1380 x 1382 pixels.
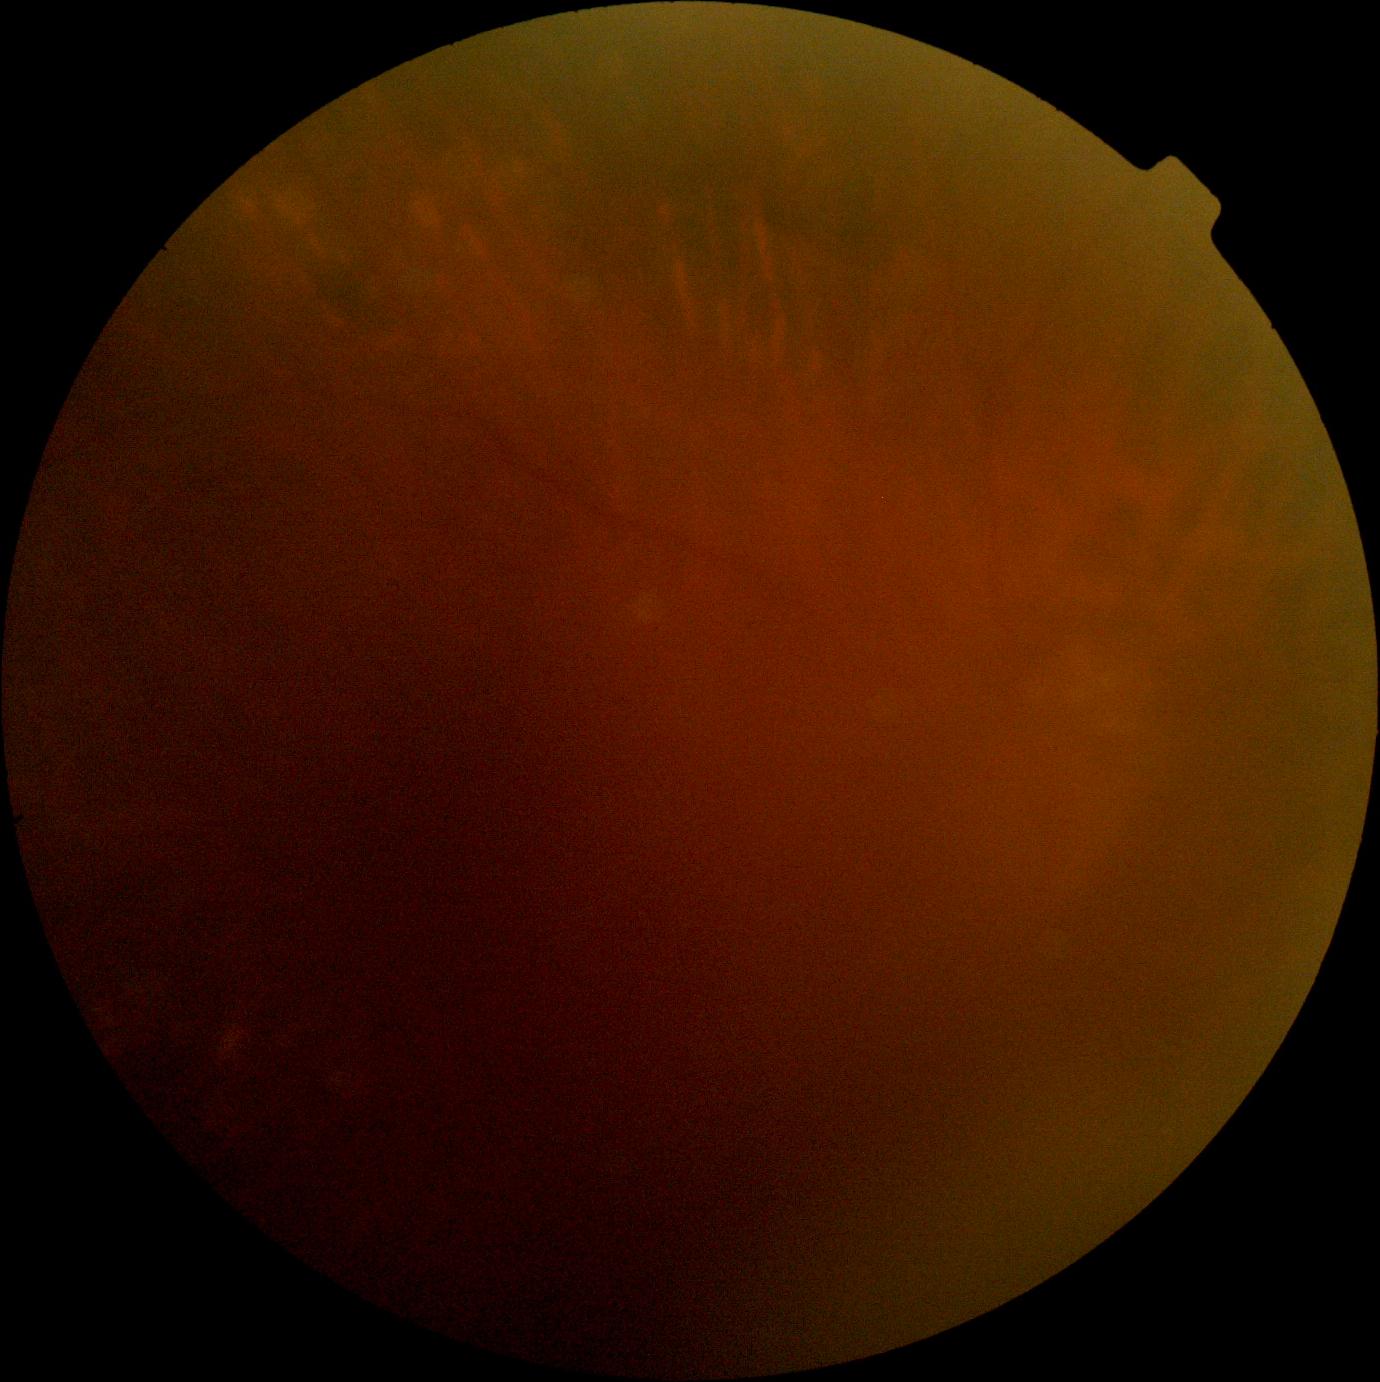 The image cannot be graded for diabetic retinopathy.
Diabetic retinopathy (DR) is ungradable.